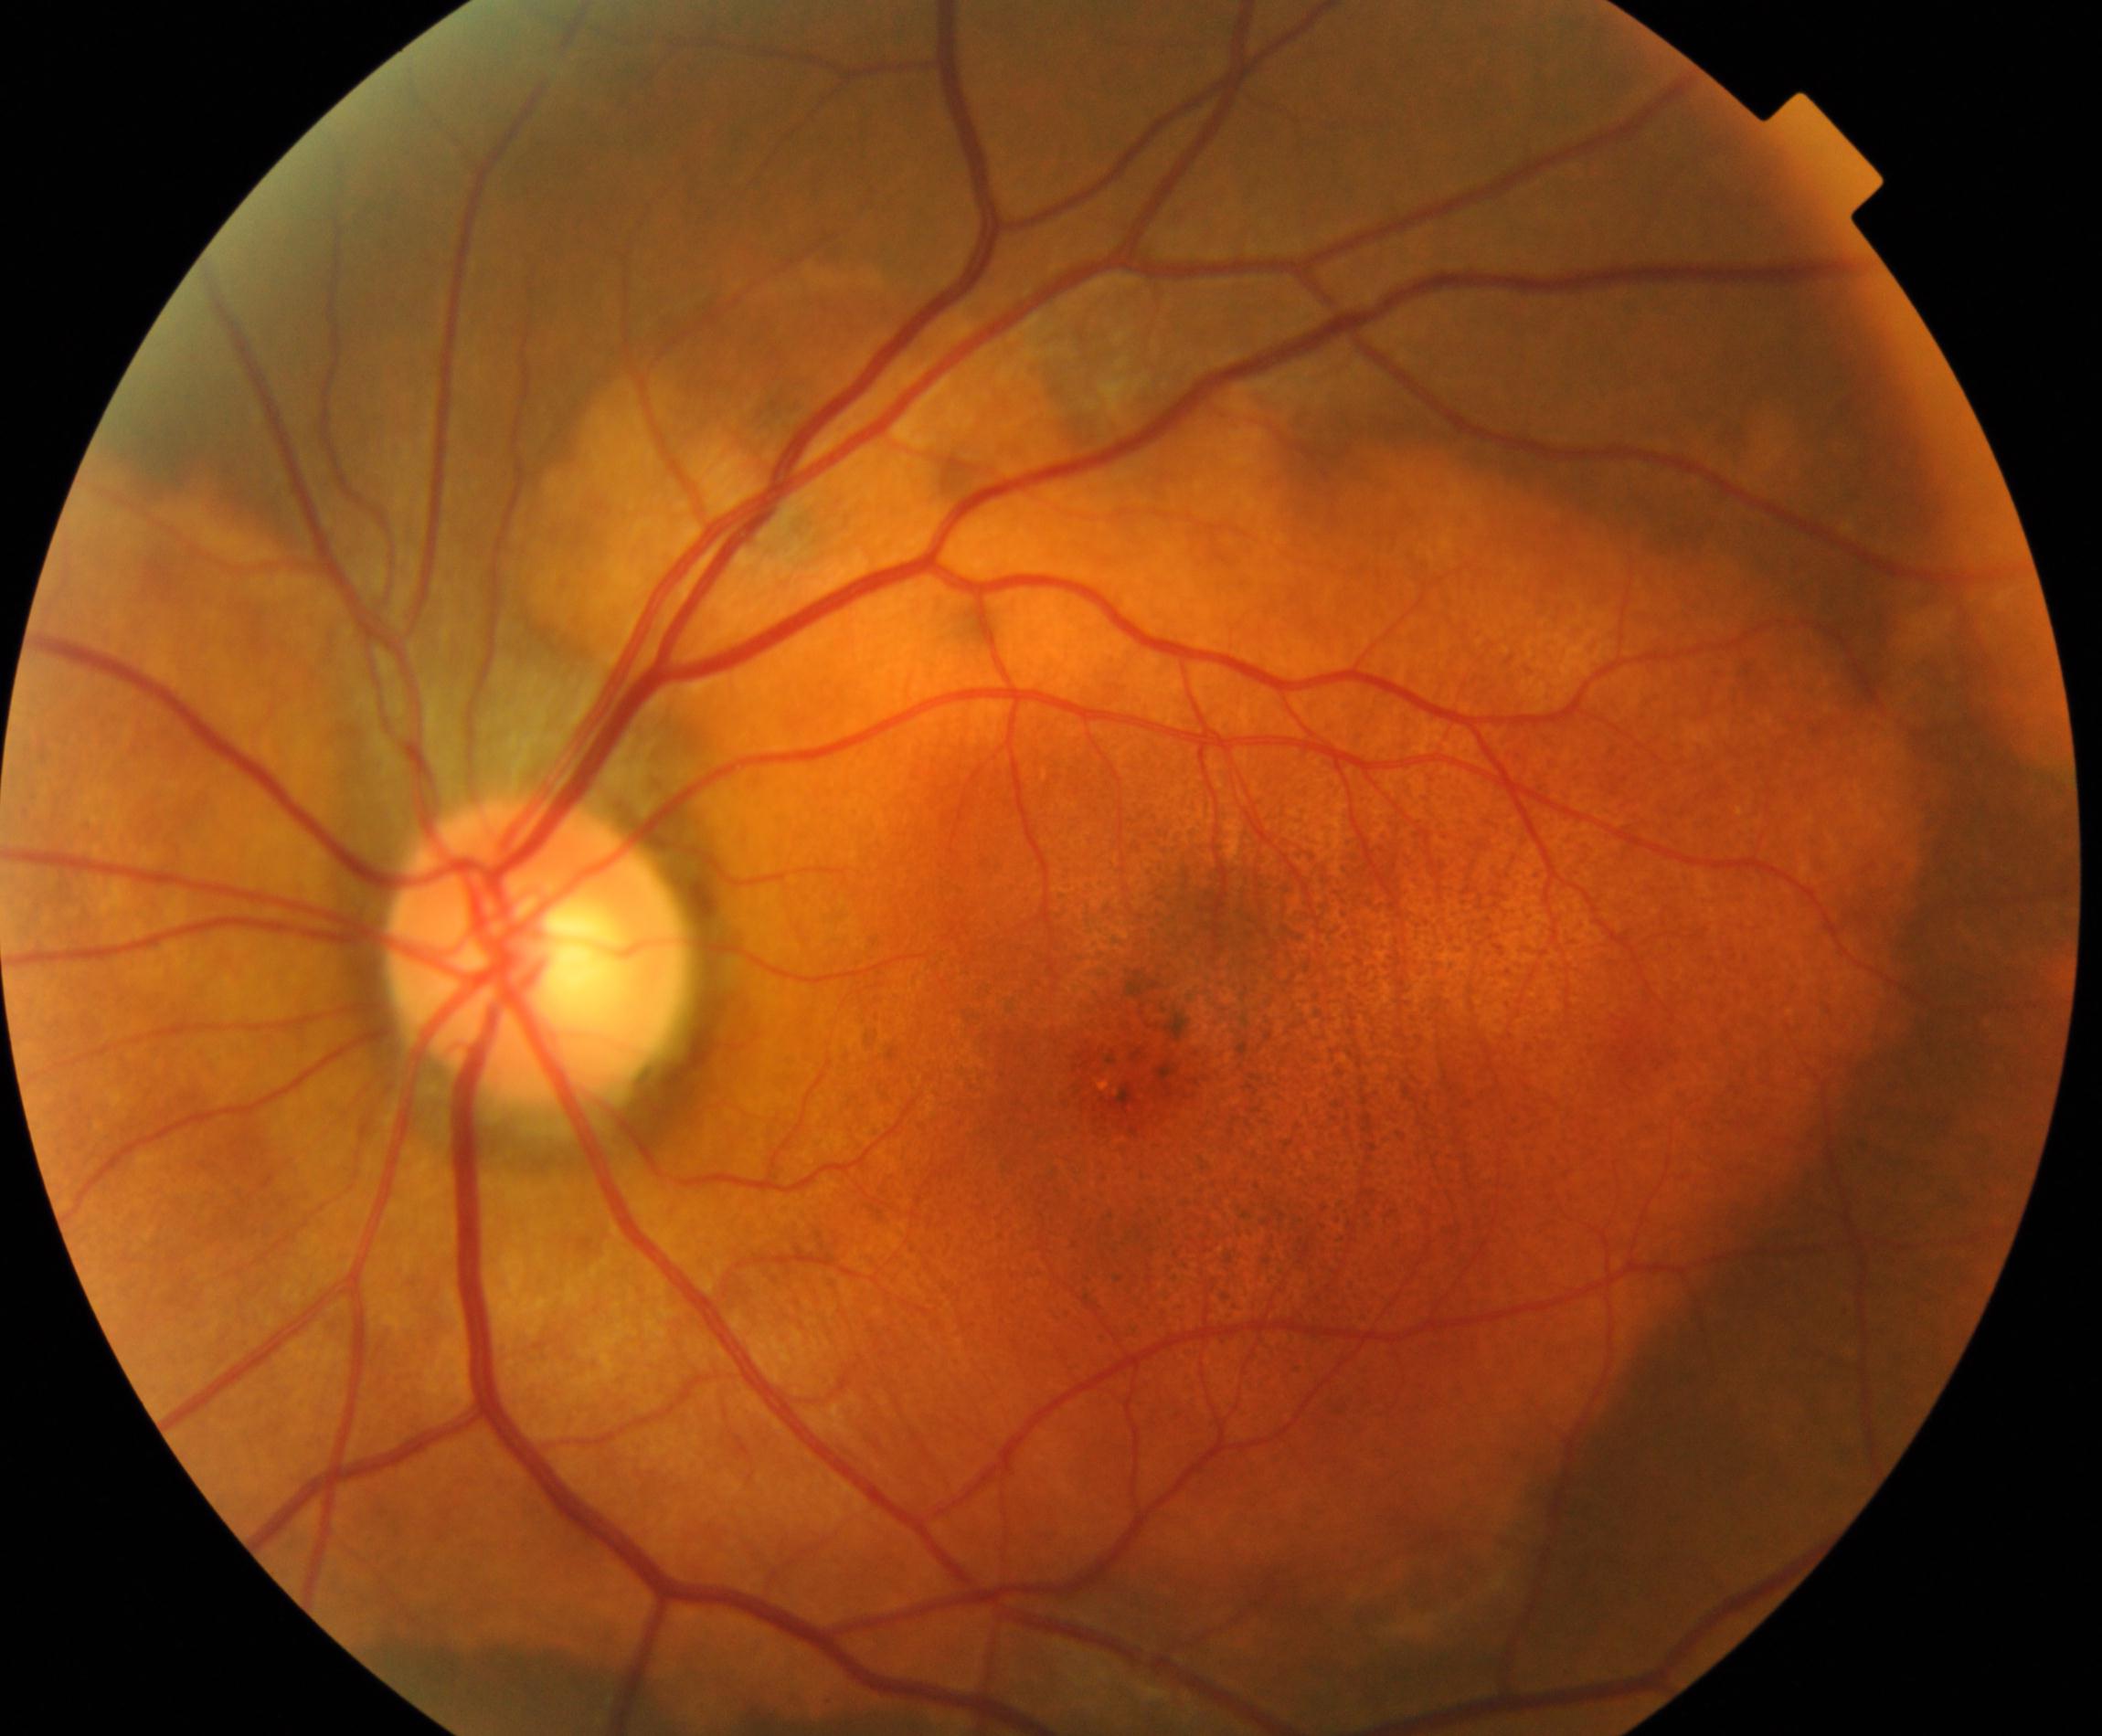
Diagnosis: fundus neoplasm.